Image size 1240x1240. Wide-field fundus photograph from neonatal ROP screening. 100° field of view (Phoenix ICON) — 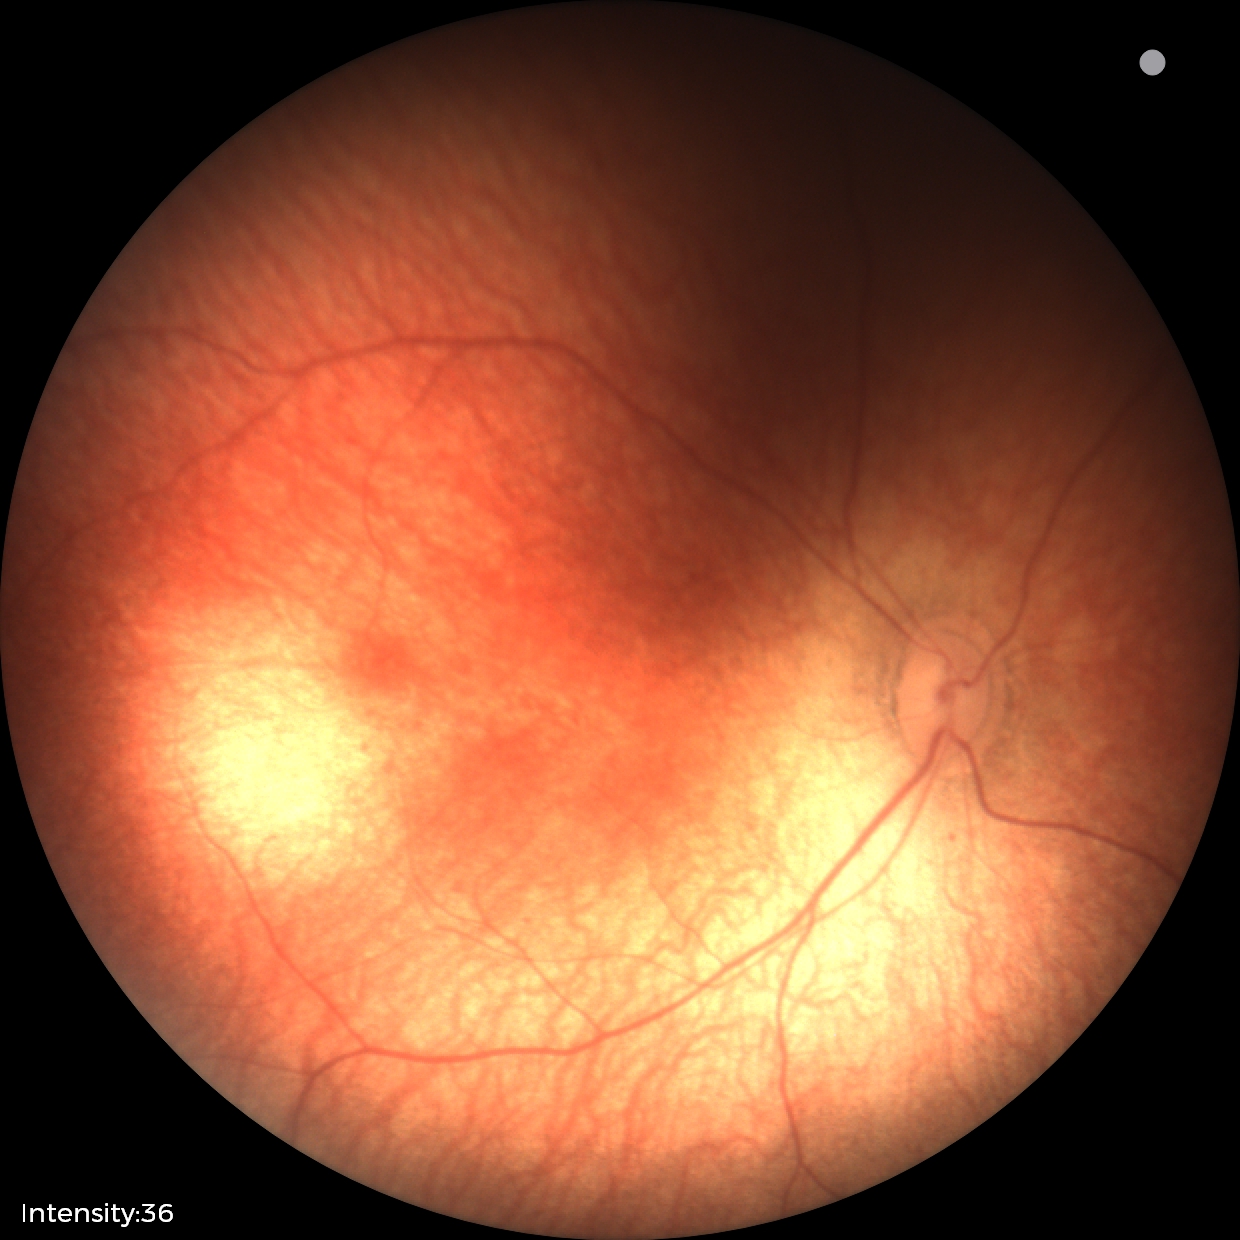 Physiological retinal appearance for postconceptual age.